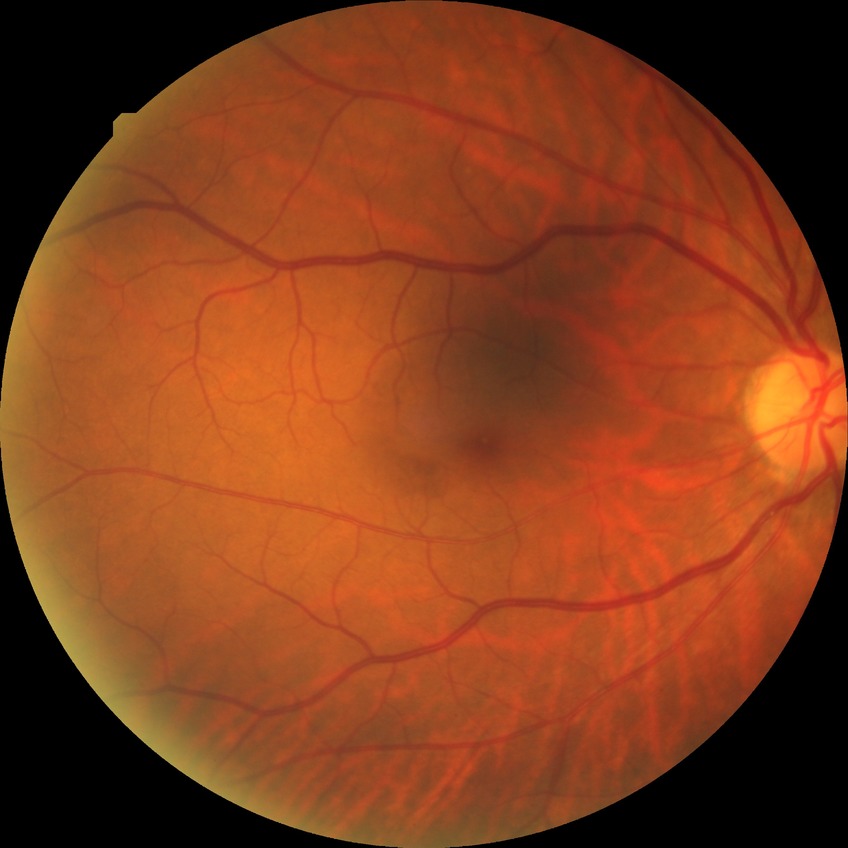 davis_grade: no diabetic retinopathy